Macula-centered.
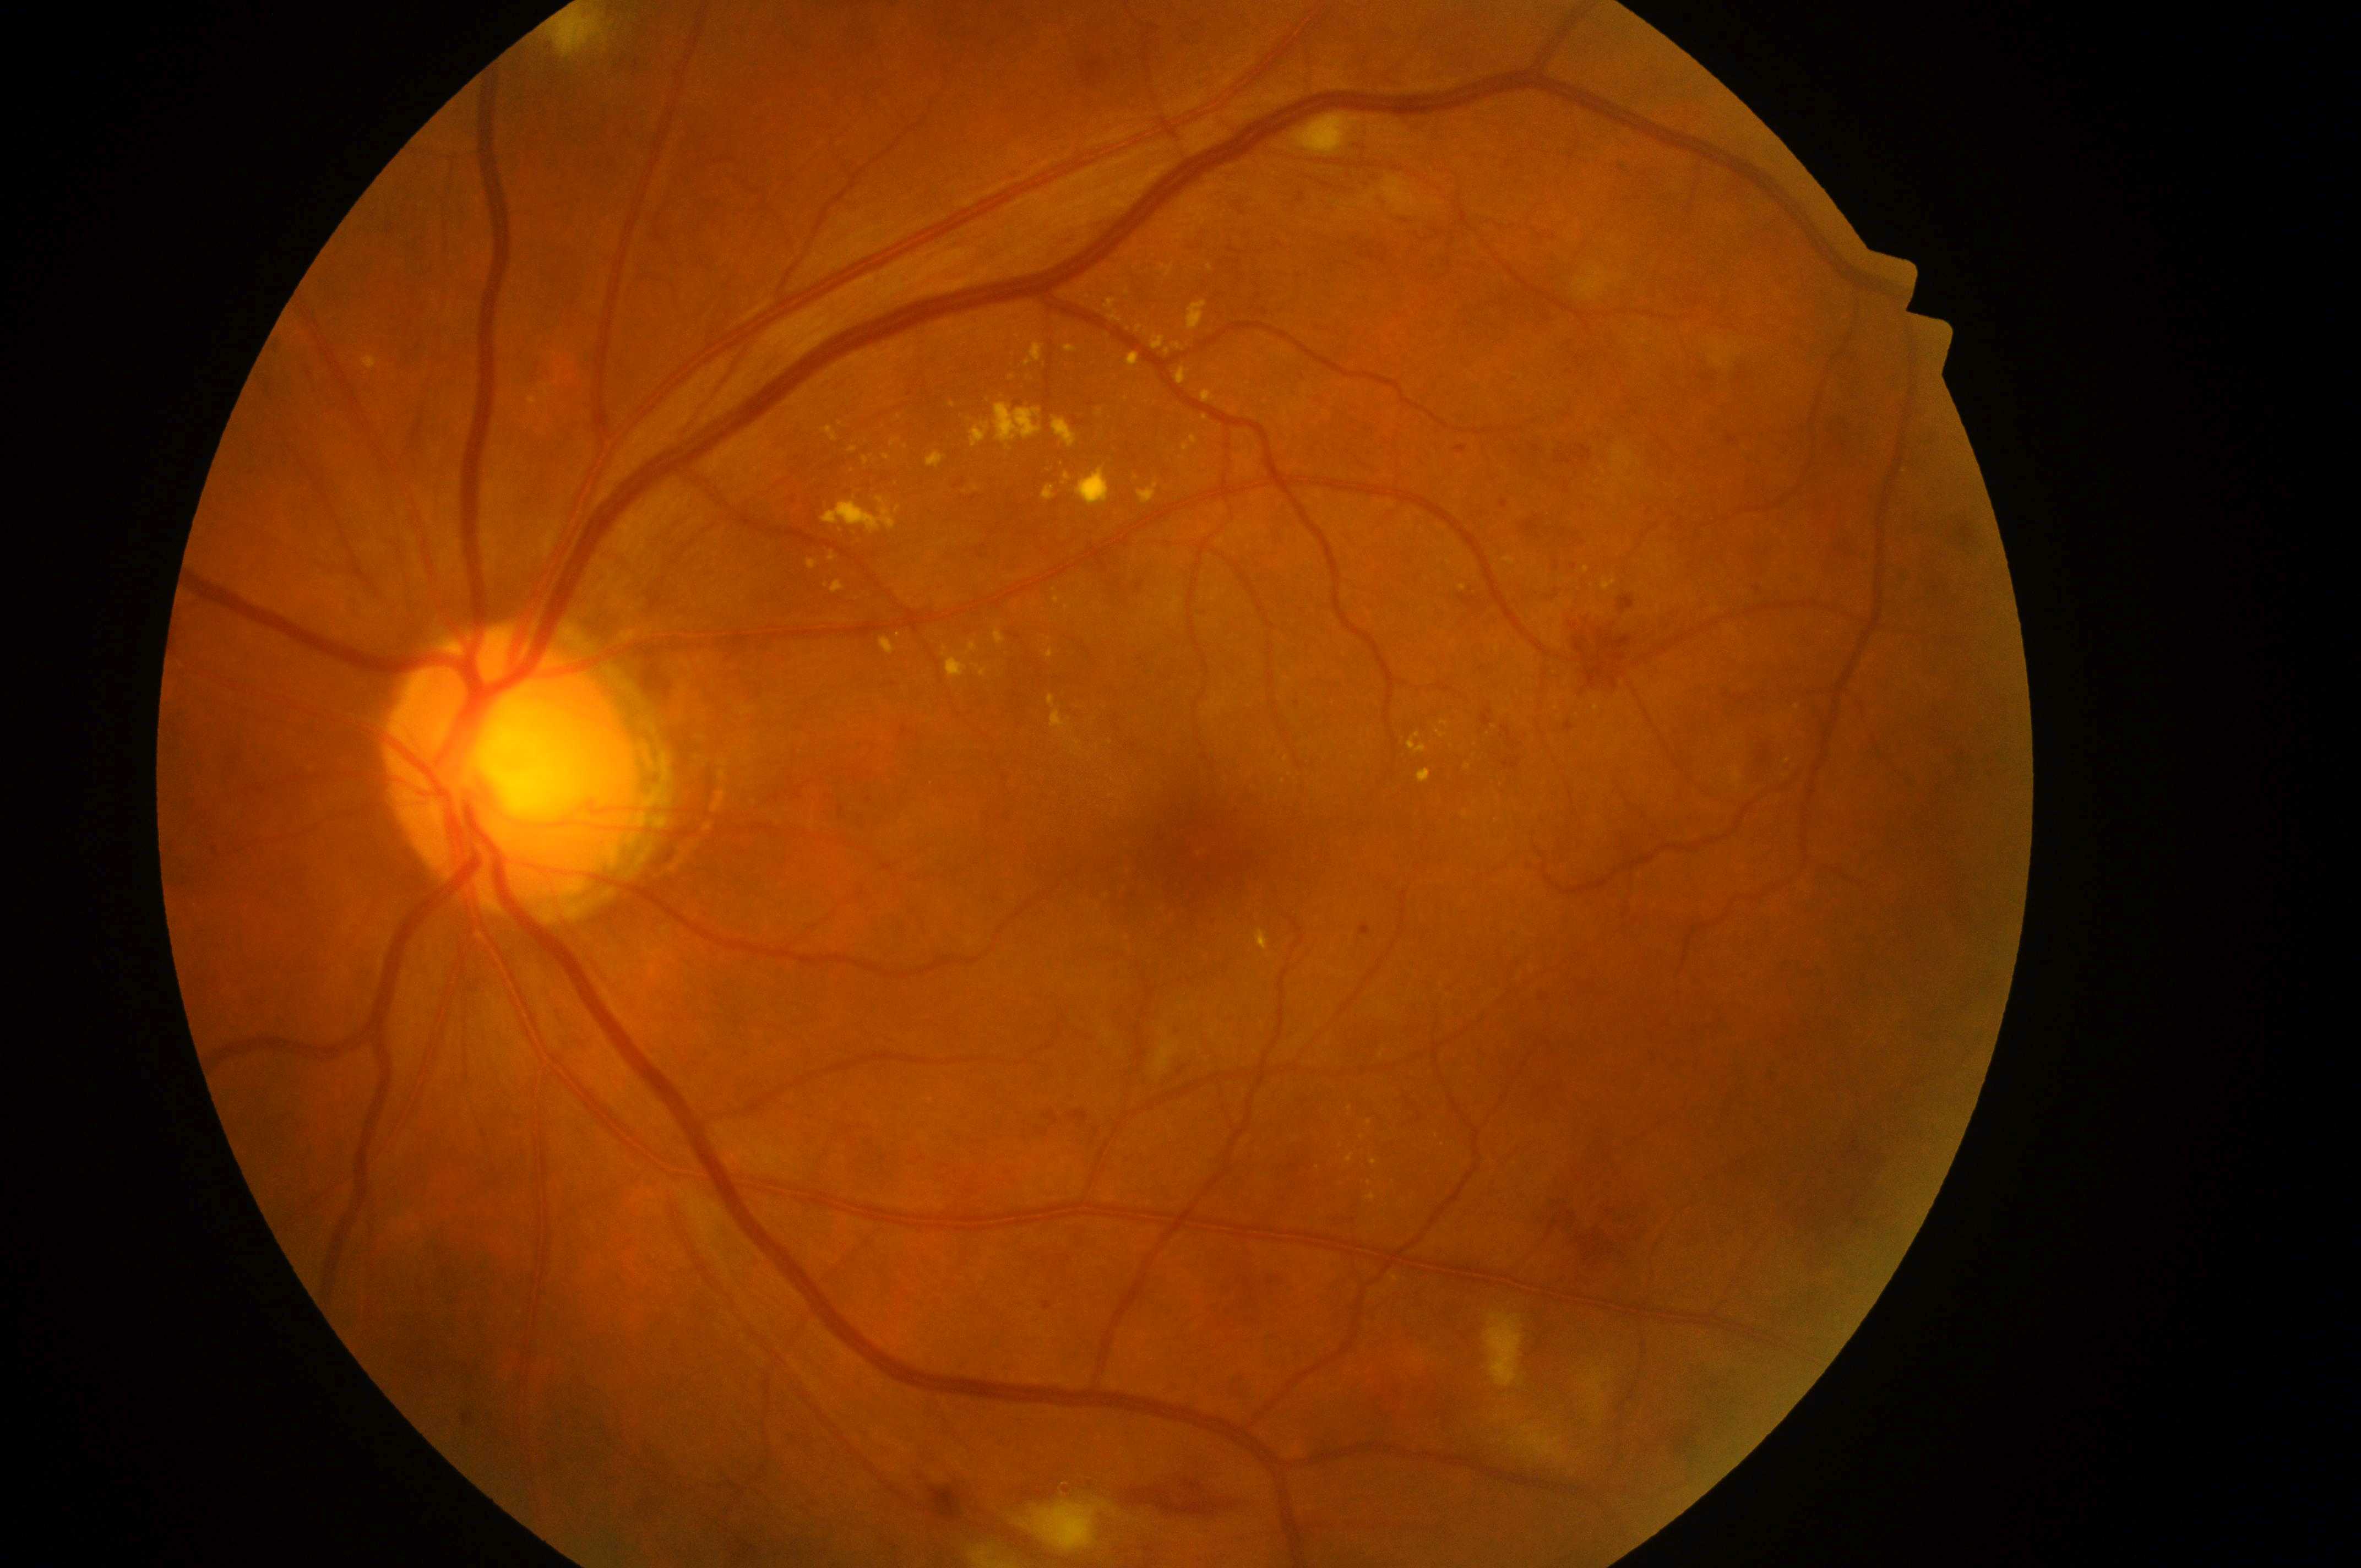

the optic disc: (509,777); non-proliferative diabetic retinopathy; DME risk: 2; fovea: (1203,851); left eye; DR grade: 3/4.